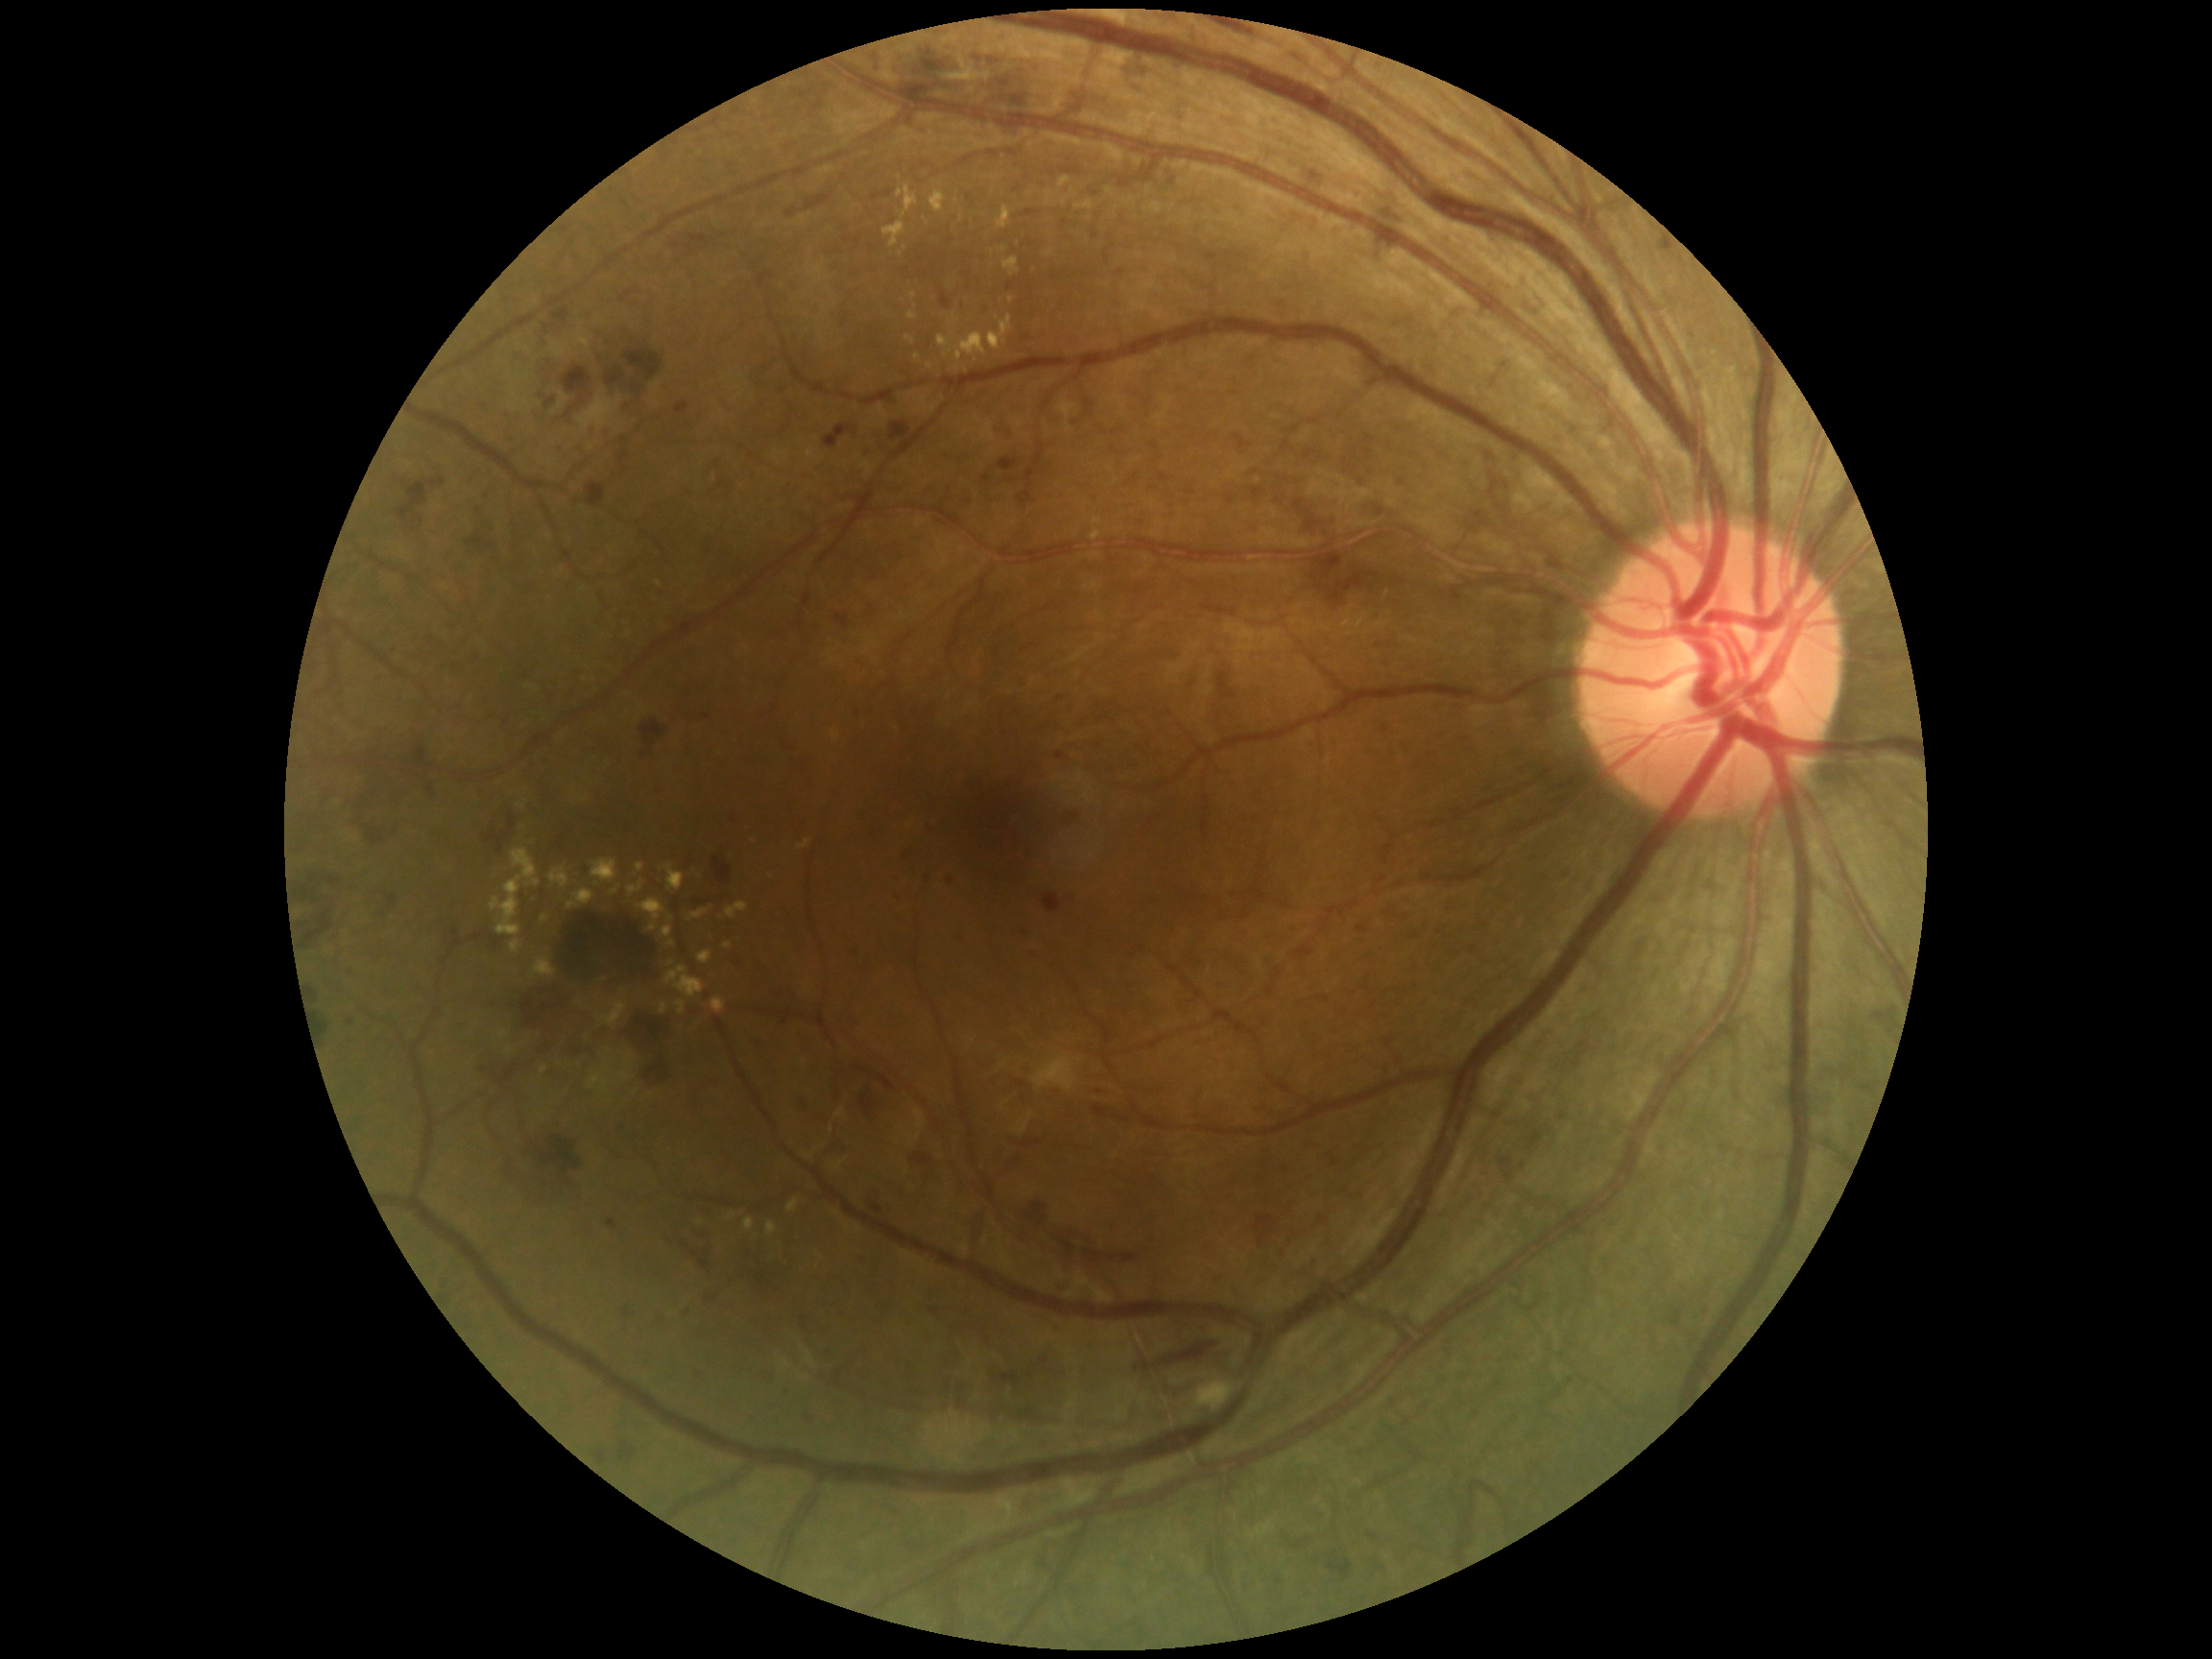

Diabetic retinopathy (DR) is 3.
Microaneurysms (MAs) include lesions at BBox(581, 863, 593, 876), BBox(1024, 932, 1033, 939), BBox(1366, 450, 1373, 458), BBox(899, 894, 902, 902), BBox(664, 383, 670, 391), BBox(588, 423, 595, 431), BBox(984, 474, 990, 484), BBox(1358, 926, 1367, 934), BBox(1054, 1326, 1064, 1335), BBox(1032, 951, 1040, 958).
Additional small MAs near [478,510], [768,1373], [351,971], [899,877], [1061,699], [568,417], [686,1314], [351,1024], [714,1300], [1060,1096].
Hard exudates (EXs) include lesions at BBox(669, 940, 675, 949), BBox(661, 1002, 667, 1016), BBox(937, 333, 987, 362), BBox(677, 1001, 686, 1016), BBox(989, 315, 1013, 350), BBox(567, 890, 595, 909), BBox(712, 998, 725, 1014), BBox(767, 1221, 779, 1236), BBox(667, 963, 675, 968), BBox(1093, 517, 1102, 526), BBox(1092, 529, 1102, 541), BBox(997, 206, 1013, 230), BBox(612, 885, 621, 897), BBox(592, 860, 619, 884), BBox(1003, 257, 1021, 276).
Additional small EXs near [914,296], [700,1223], [916,307], [930,367].
Hemorrhages (HEs) include lesions at BBox(1009, 95, 1027, 108), BBox(309, 990, 319, 1003), BBox(602, 328, 636, 364), BBox(469, 532, 493, 551), BBox(314, 1013, 328, 1040), BBox(411, 526, 419, 534), BBox(518, 985, 600, 1059), BBox(631, 384, 645, 398), BBox(887, 423, 911, 438), BBox(1027, 1202, 1049, 1228), BBox(619, 1445, 636, 1464), BBox(1379, 206, 1405, 223), BBox(295, 876, 343, 939), BBox(553, 307, 569, 324), BBox(998, 80, 1011, 89), BBox(646, 1062, 677, 1092), BBox(640, 720, 667, 748), BBox(1069, 1240, 1149, 1268).